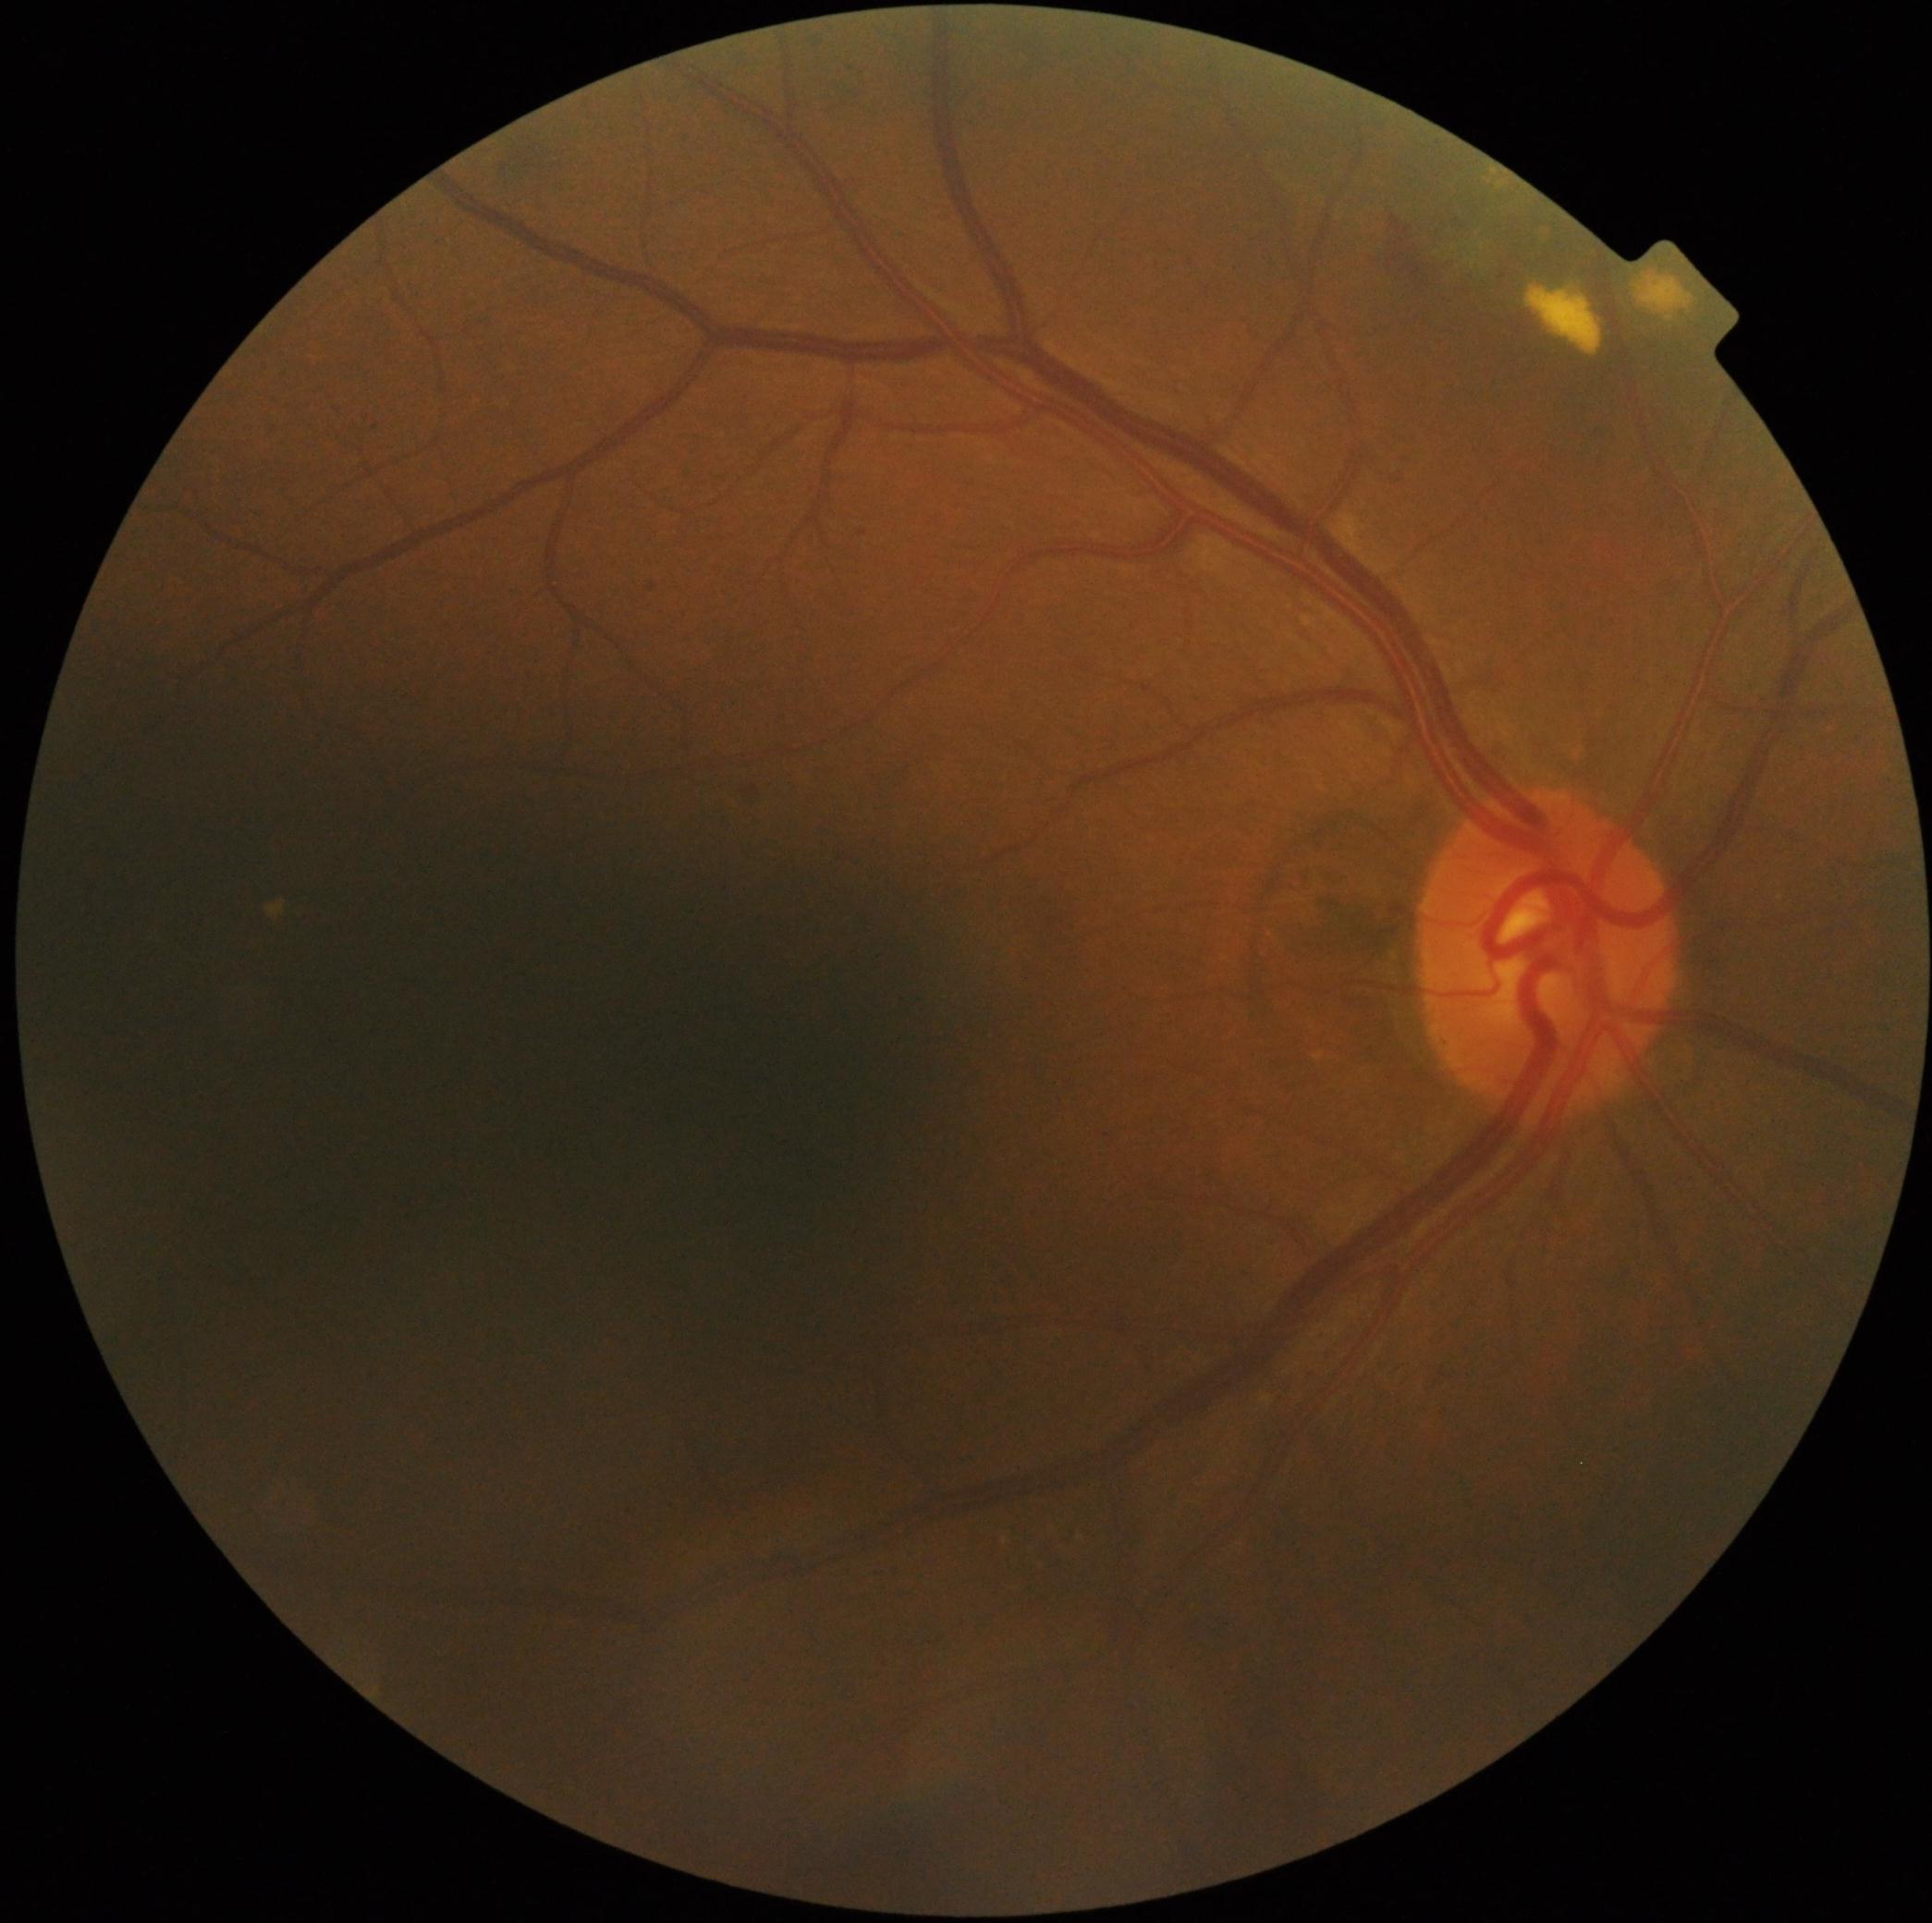
DR class=non-proliferative diabetic retinopathy; DR severity=grade 2.